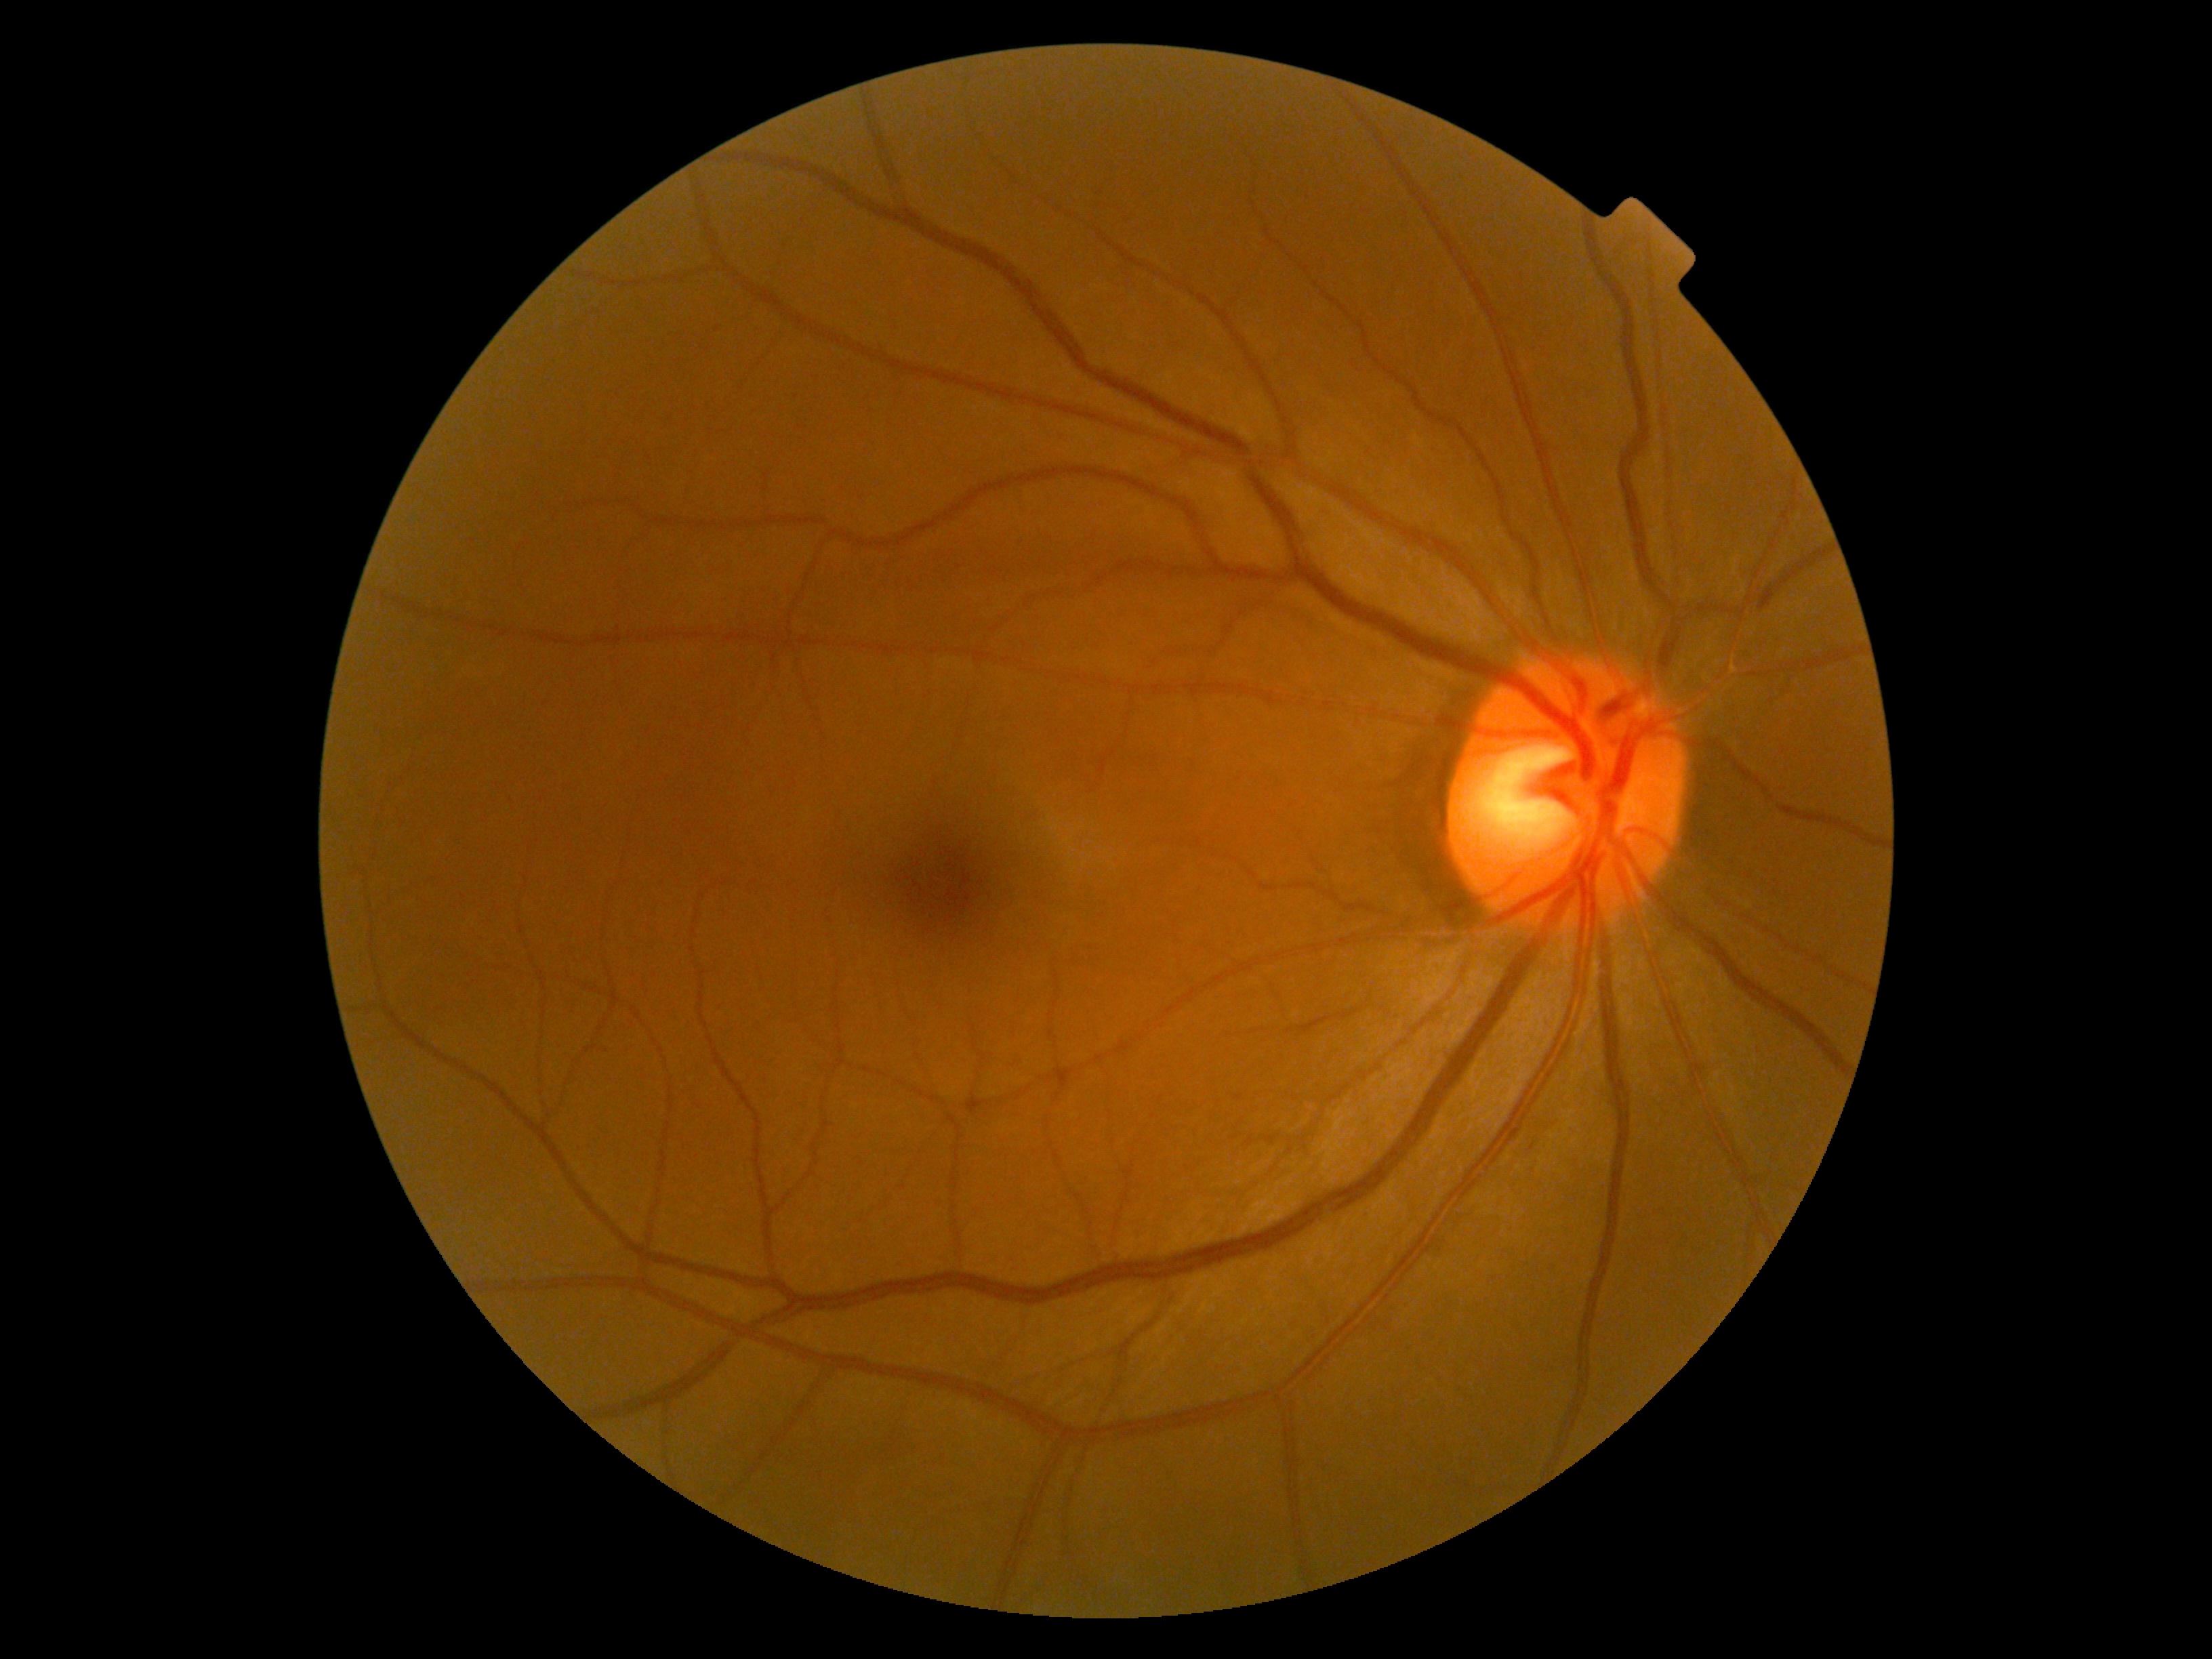 DR severity: no apparent diabetic retinopathy (grade 0).